Retinal fundus photograph. Acquired with a NIDEK AFC-230. 848x848. Nonmydriatic fundus photograph
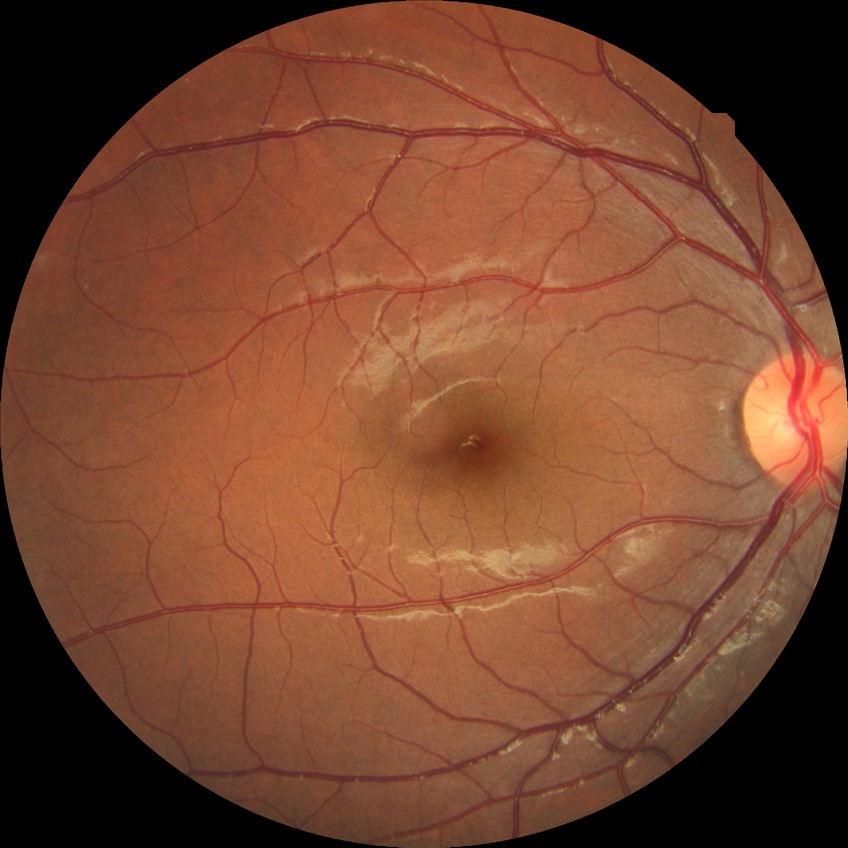

Diabetic retinopathy (DR): no diabetic retinopathy (NDR).